Modified Davis grading — 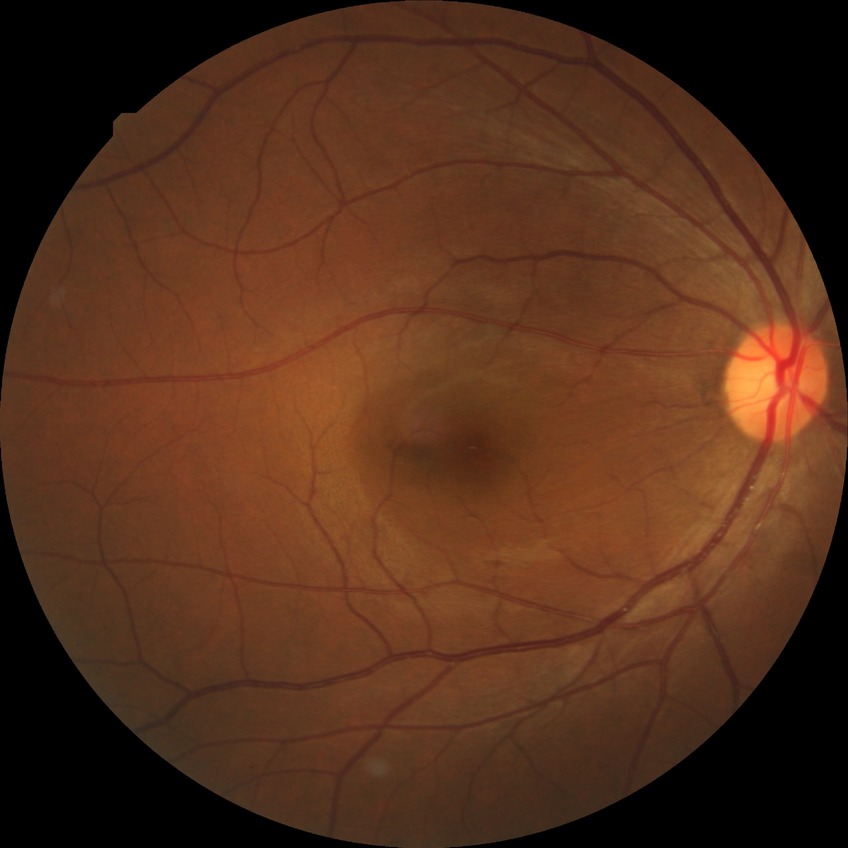

retinopathy grade: simple diabetic retinopathy